CFP: 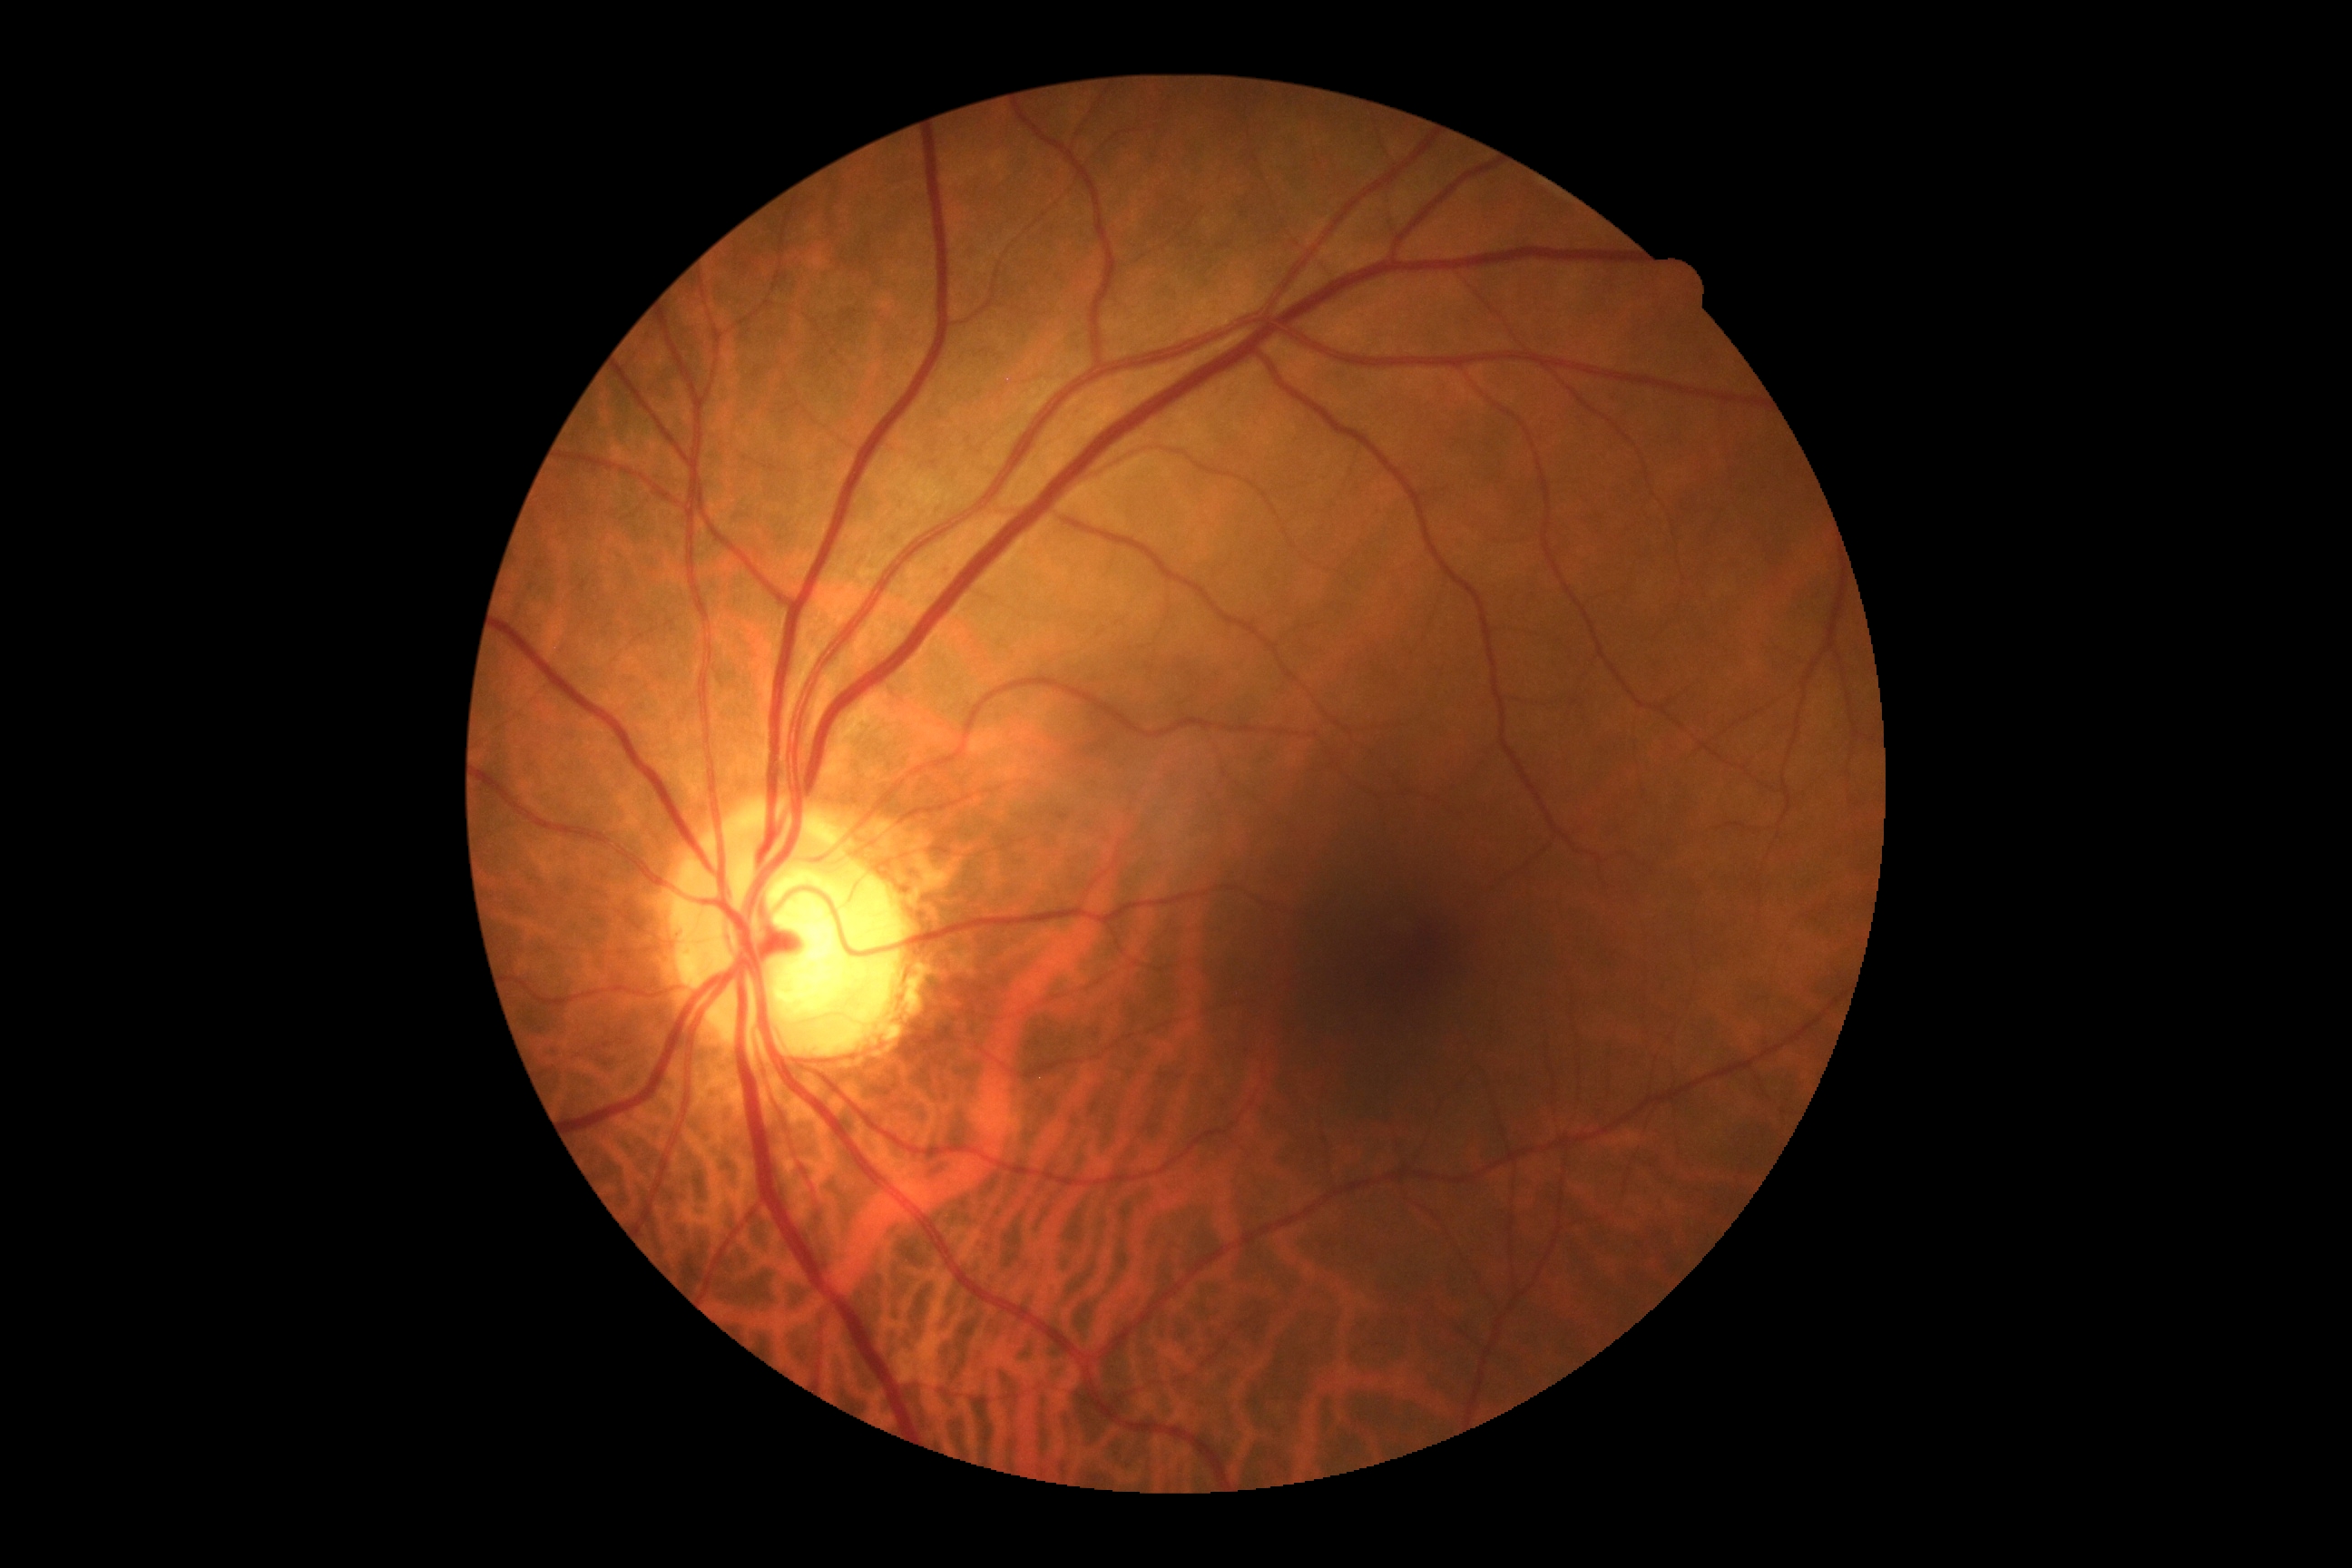 DR impression@no DR findings, DR grade@no apparent retinopathy (0) — no visible signs of diabetic retinopathy.